Retinal fundus photograph. 2212x1659px:
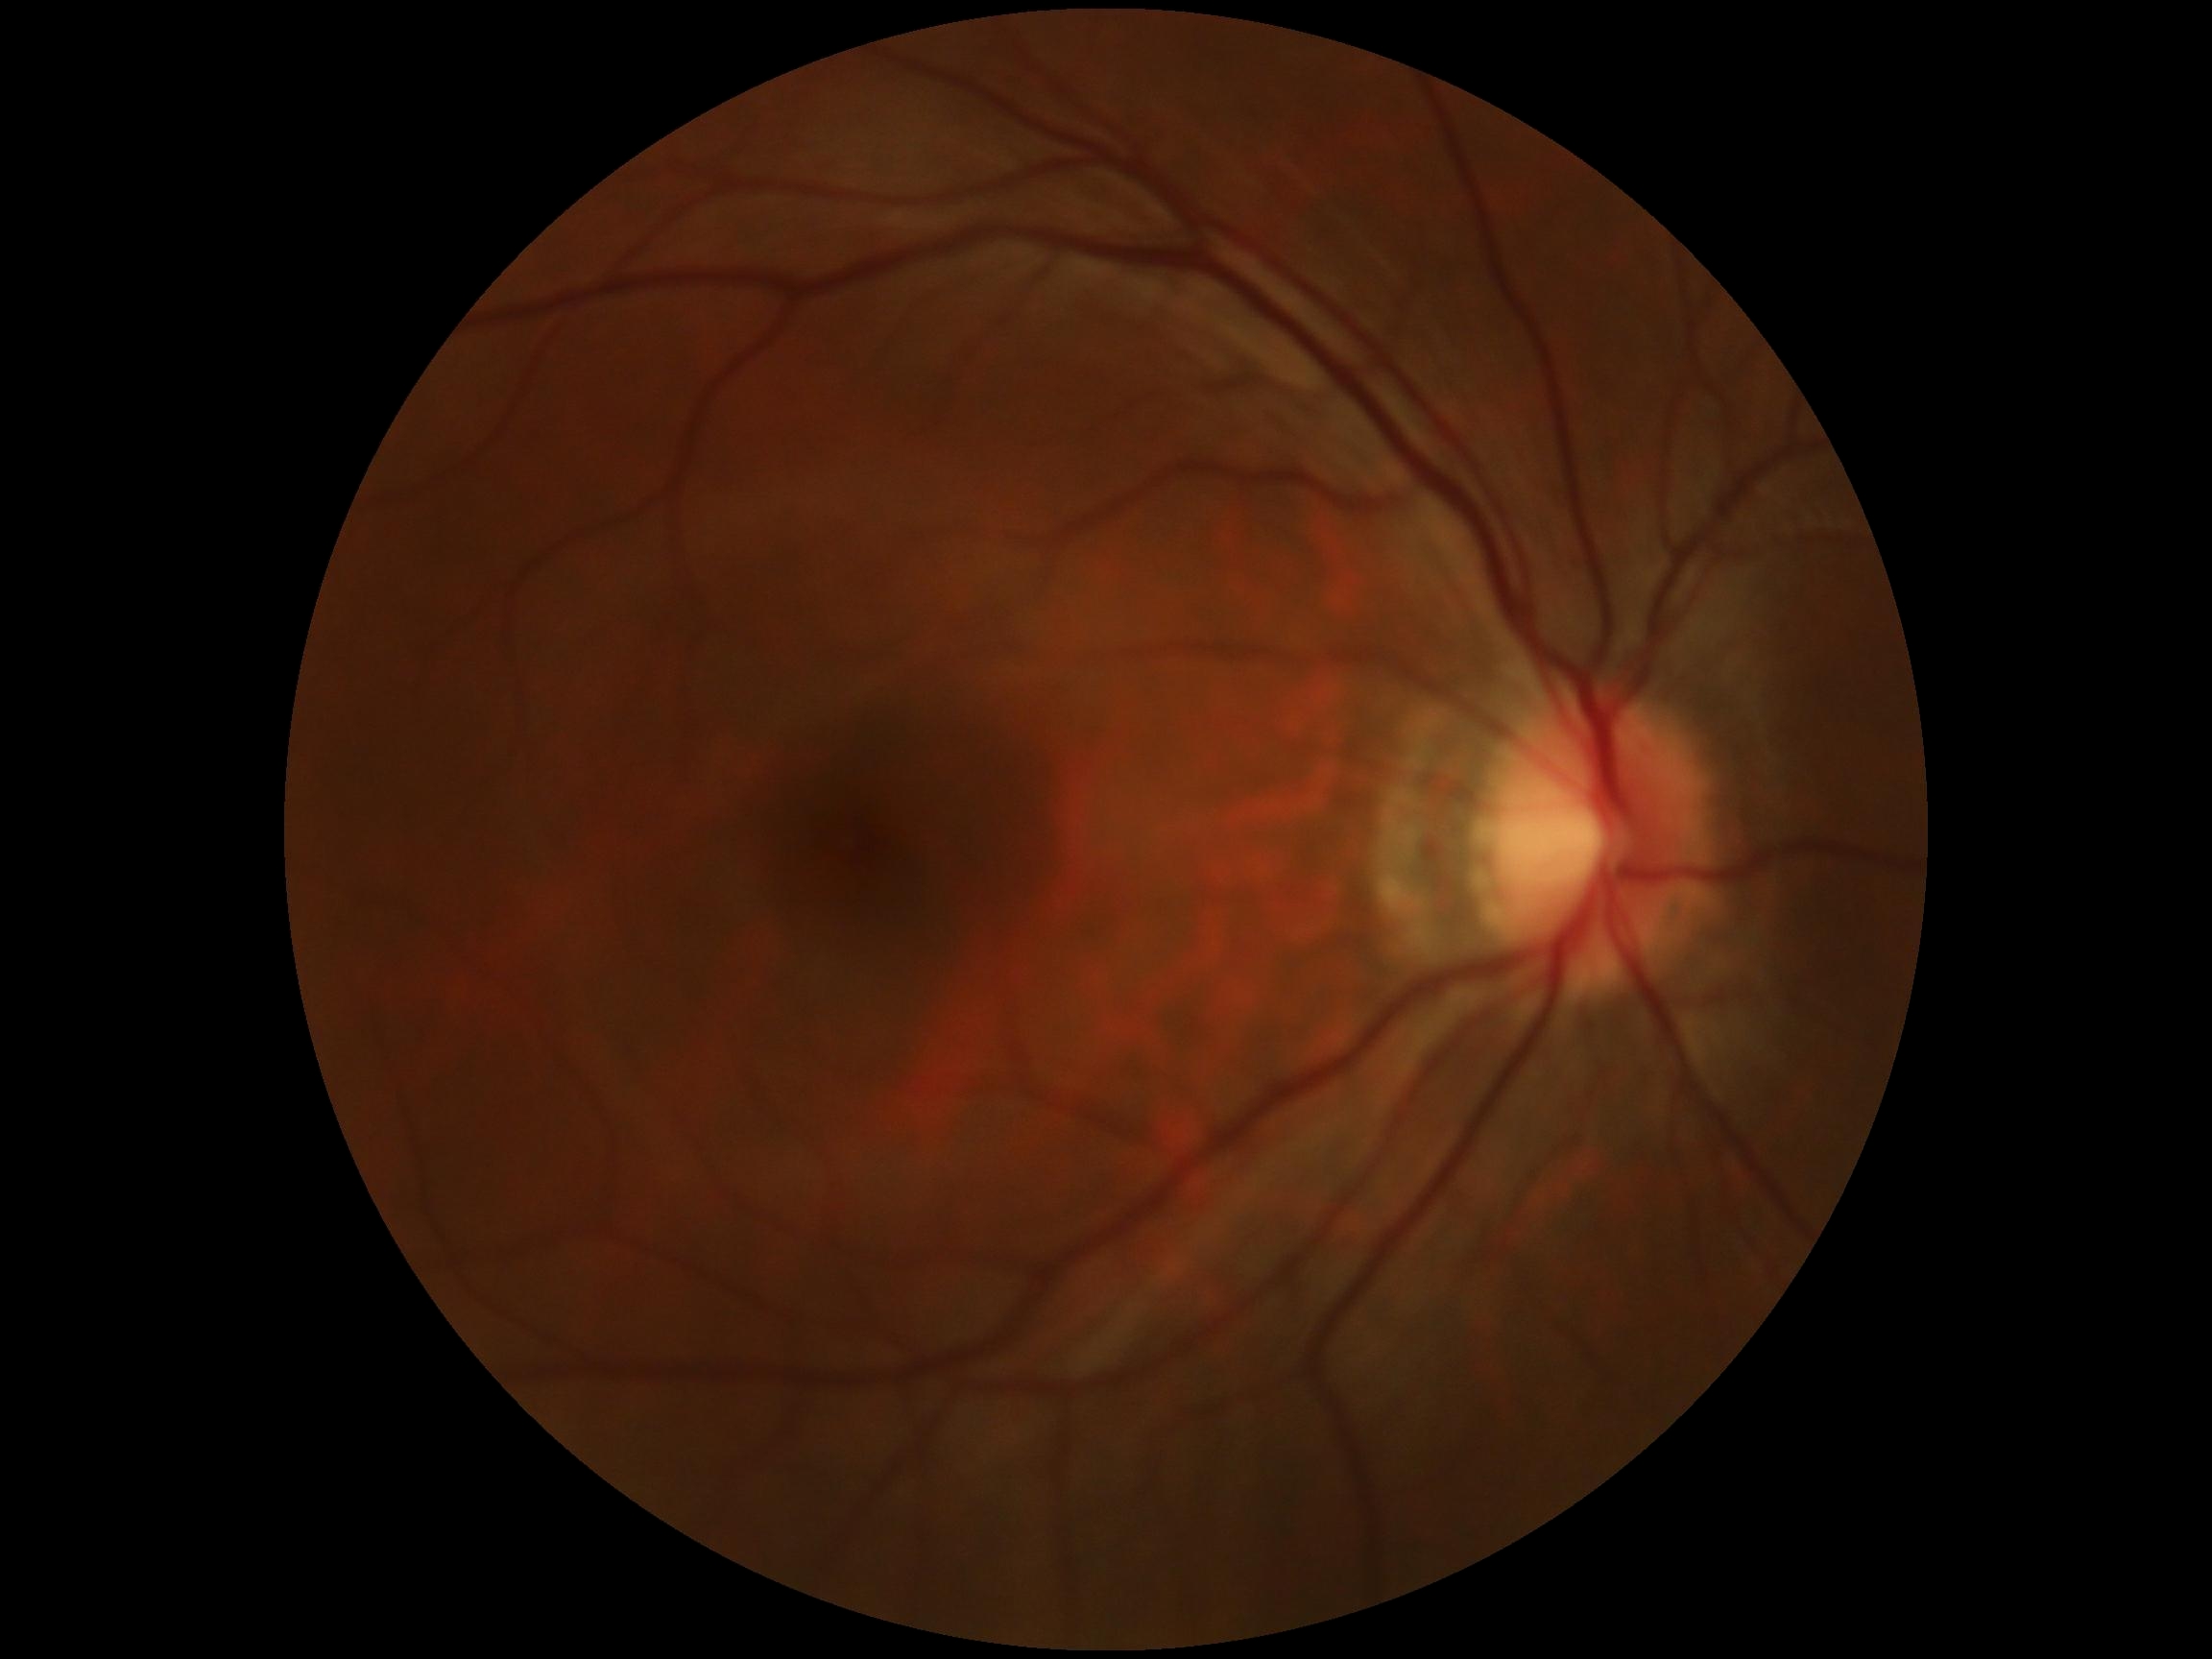
Retinopathy: 0/4.